Retinal fundus photograph · optic disc region crop:
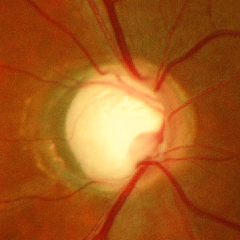 Severe glaucomatous damage.